Wide-field contact fundus photograph of an infant; captured with the Clarity RetCam 3 (130° field of view) — 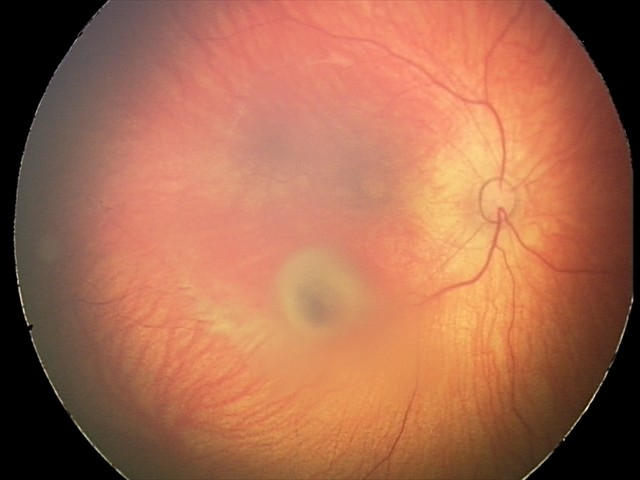
Impression: retinal hemorrhages.